512x512px — 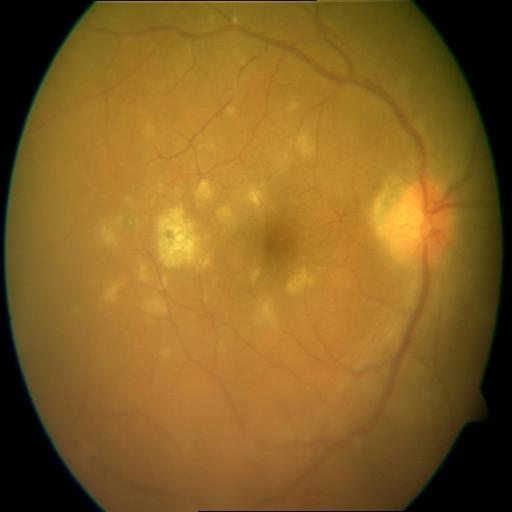
Findings consistent with CRS (chorioretinitis).